1725x1721px
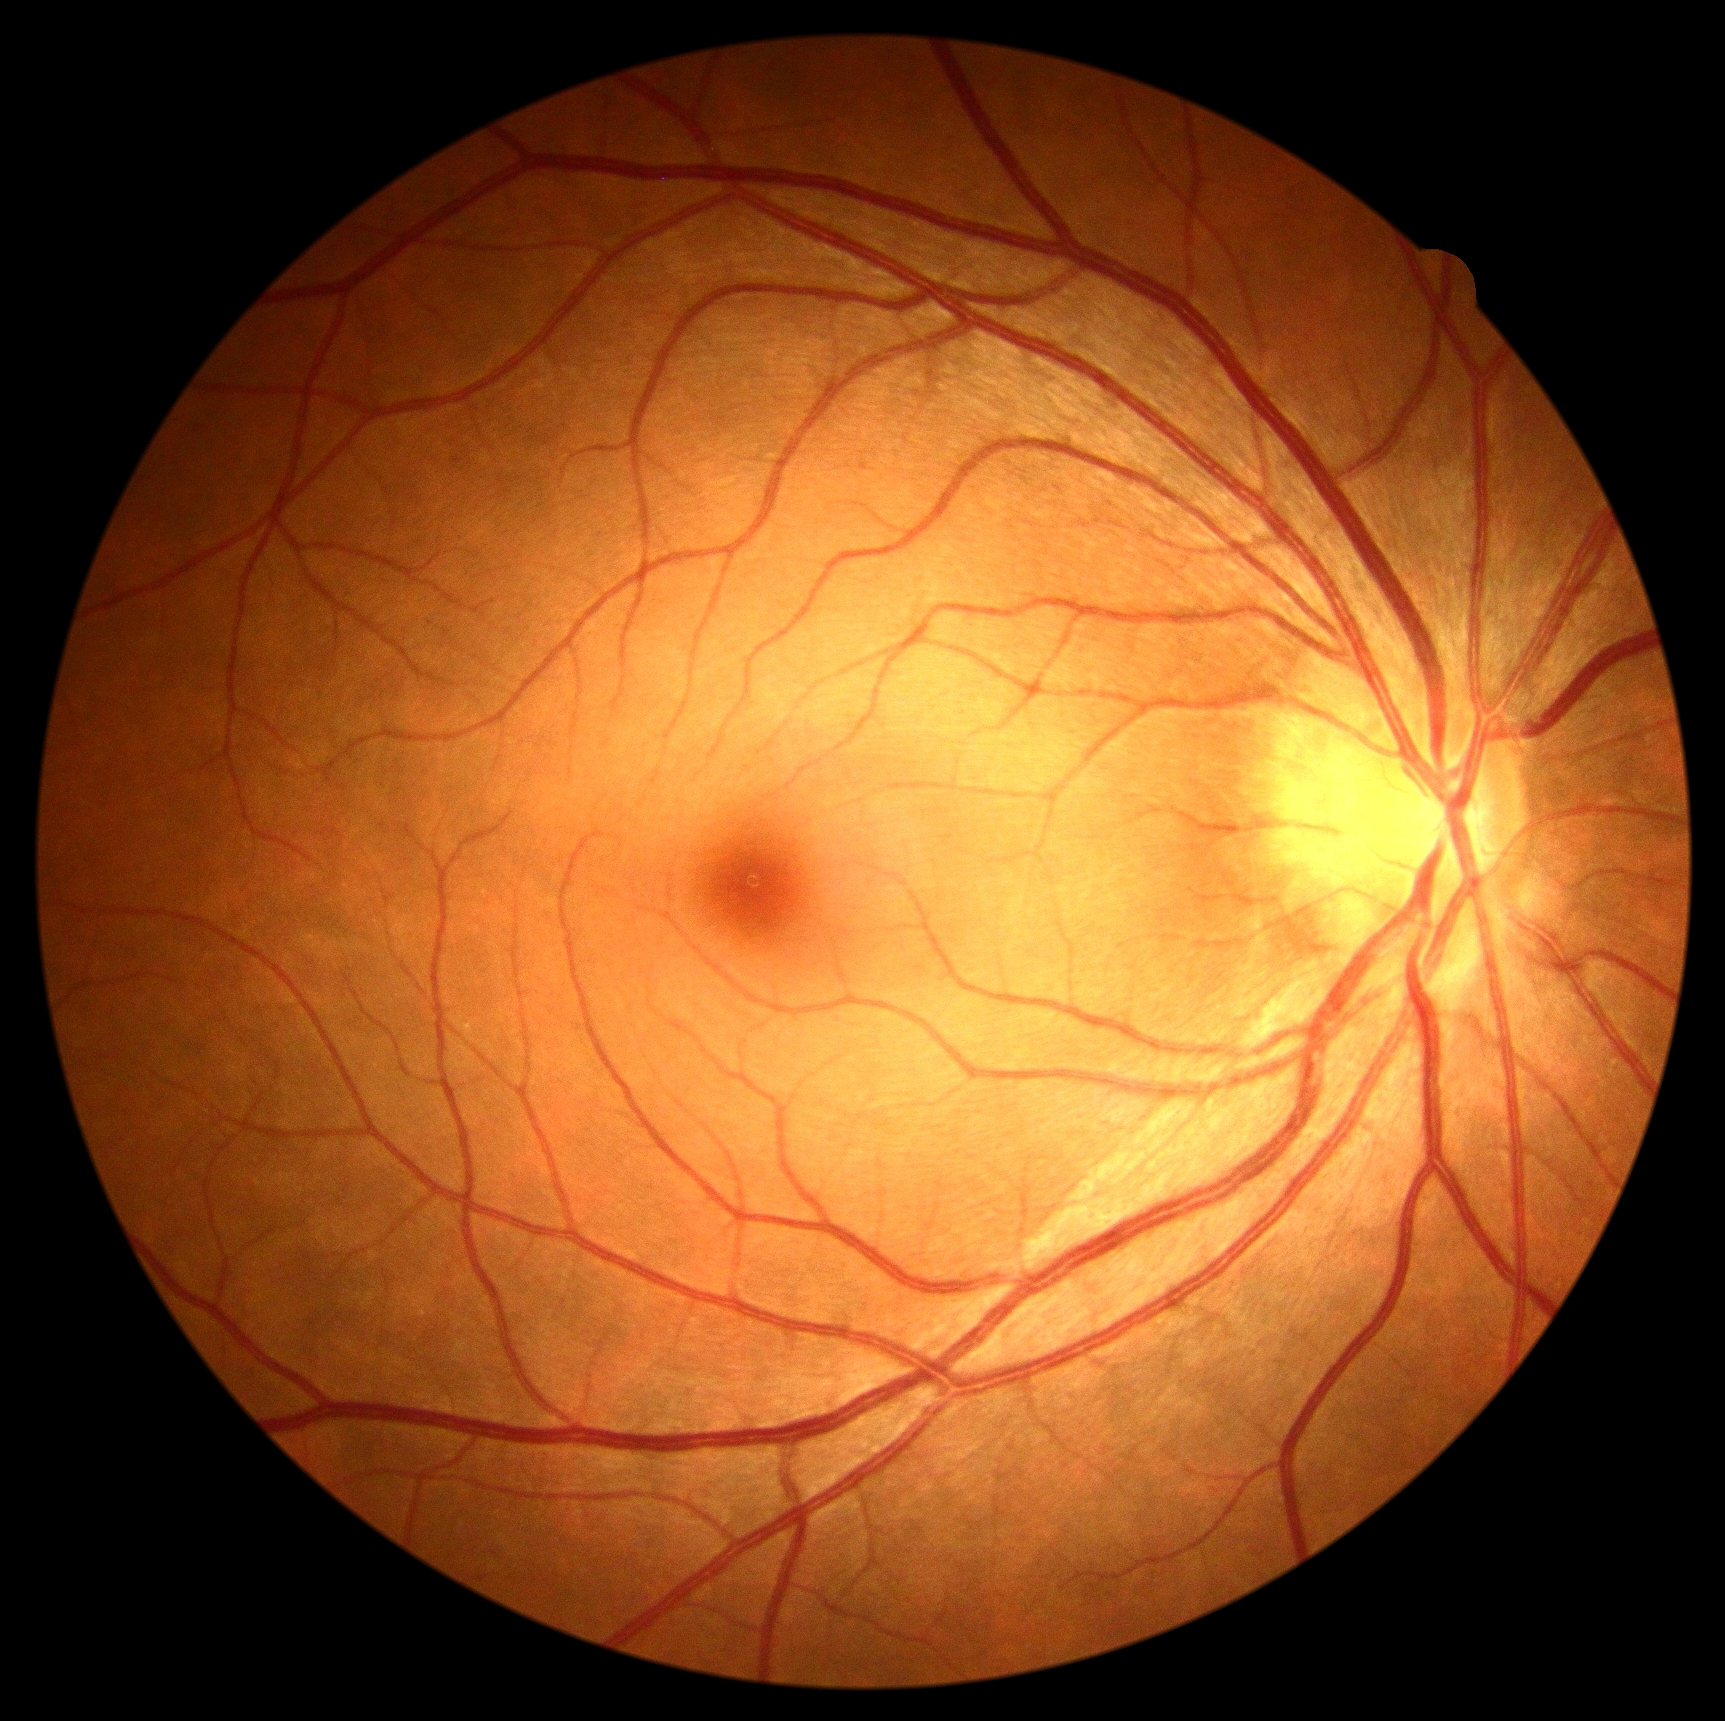

{"dr_grade": "no apparent retinopathy (grade 0)"}